Clarity RetCam 3, 130° FOV · wide-field fundus photograph from neonatal ROP screening · 640x480px:
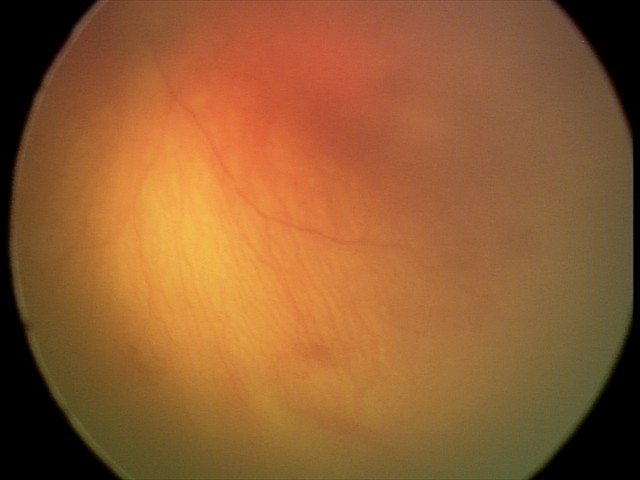

From an examination with diagnosis of aggressive retinopathy of prematurity. Plus disease was diagnosed.